45° FOV: 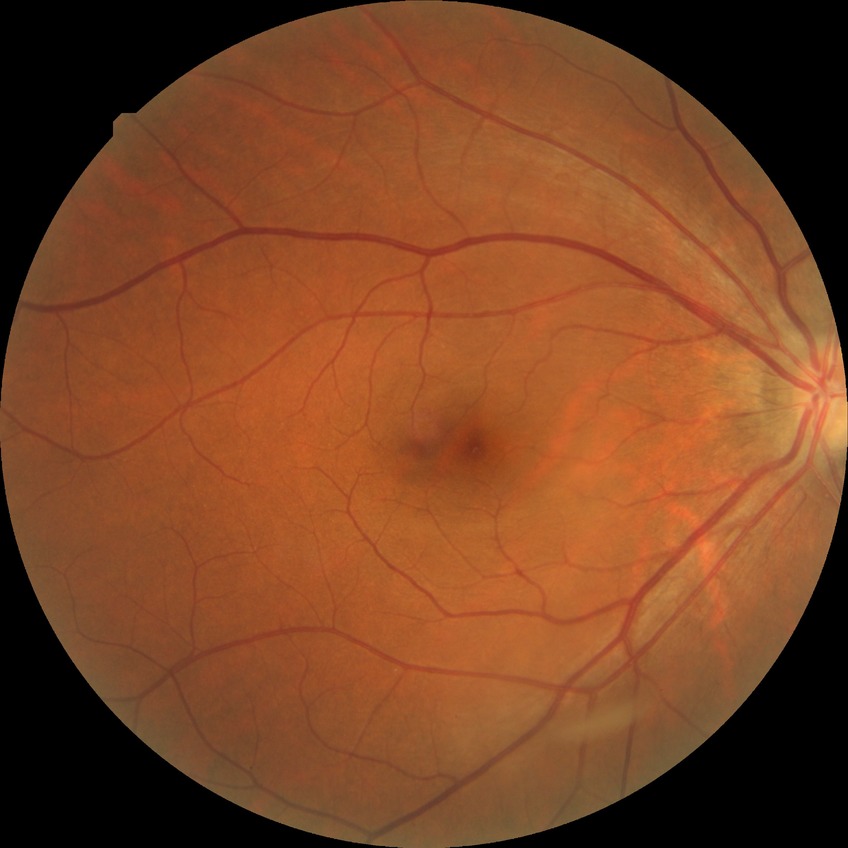
diabetic retinopathy (DR): no diabetic retinopathy (NDR).